CFP · nonmydriatic fundus photograph · camera: NIDEK AFC-230 — 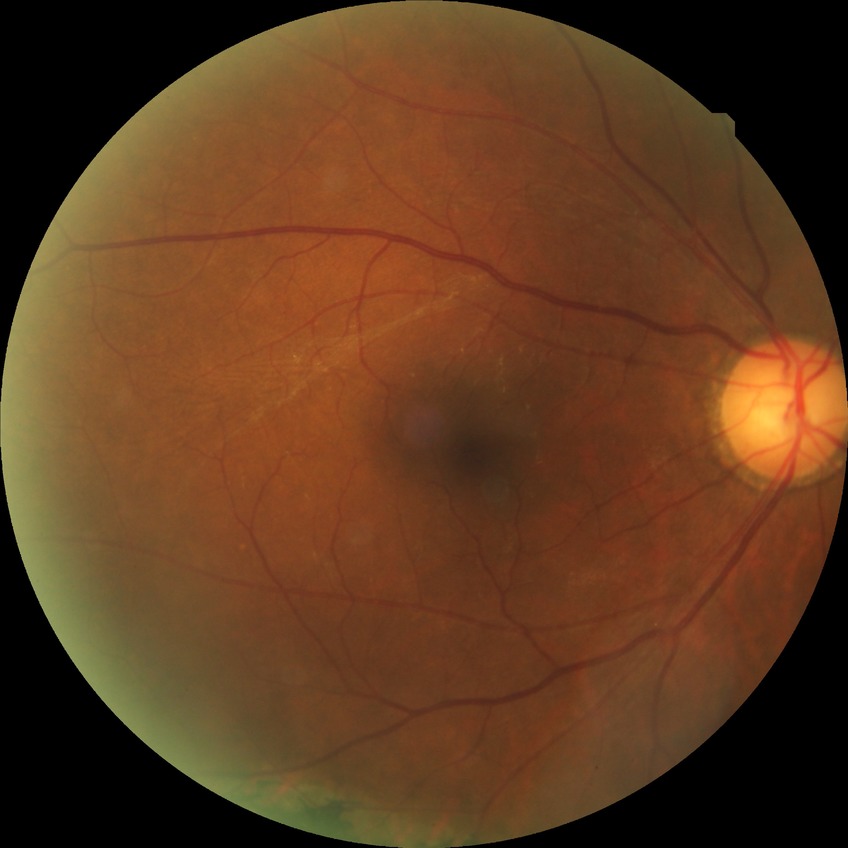

Diabetic retinopathy (DR) is no diabetic retinopathy (NDR).